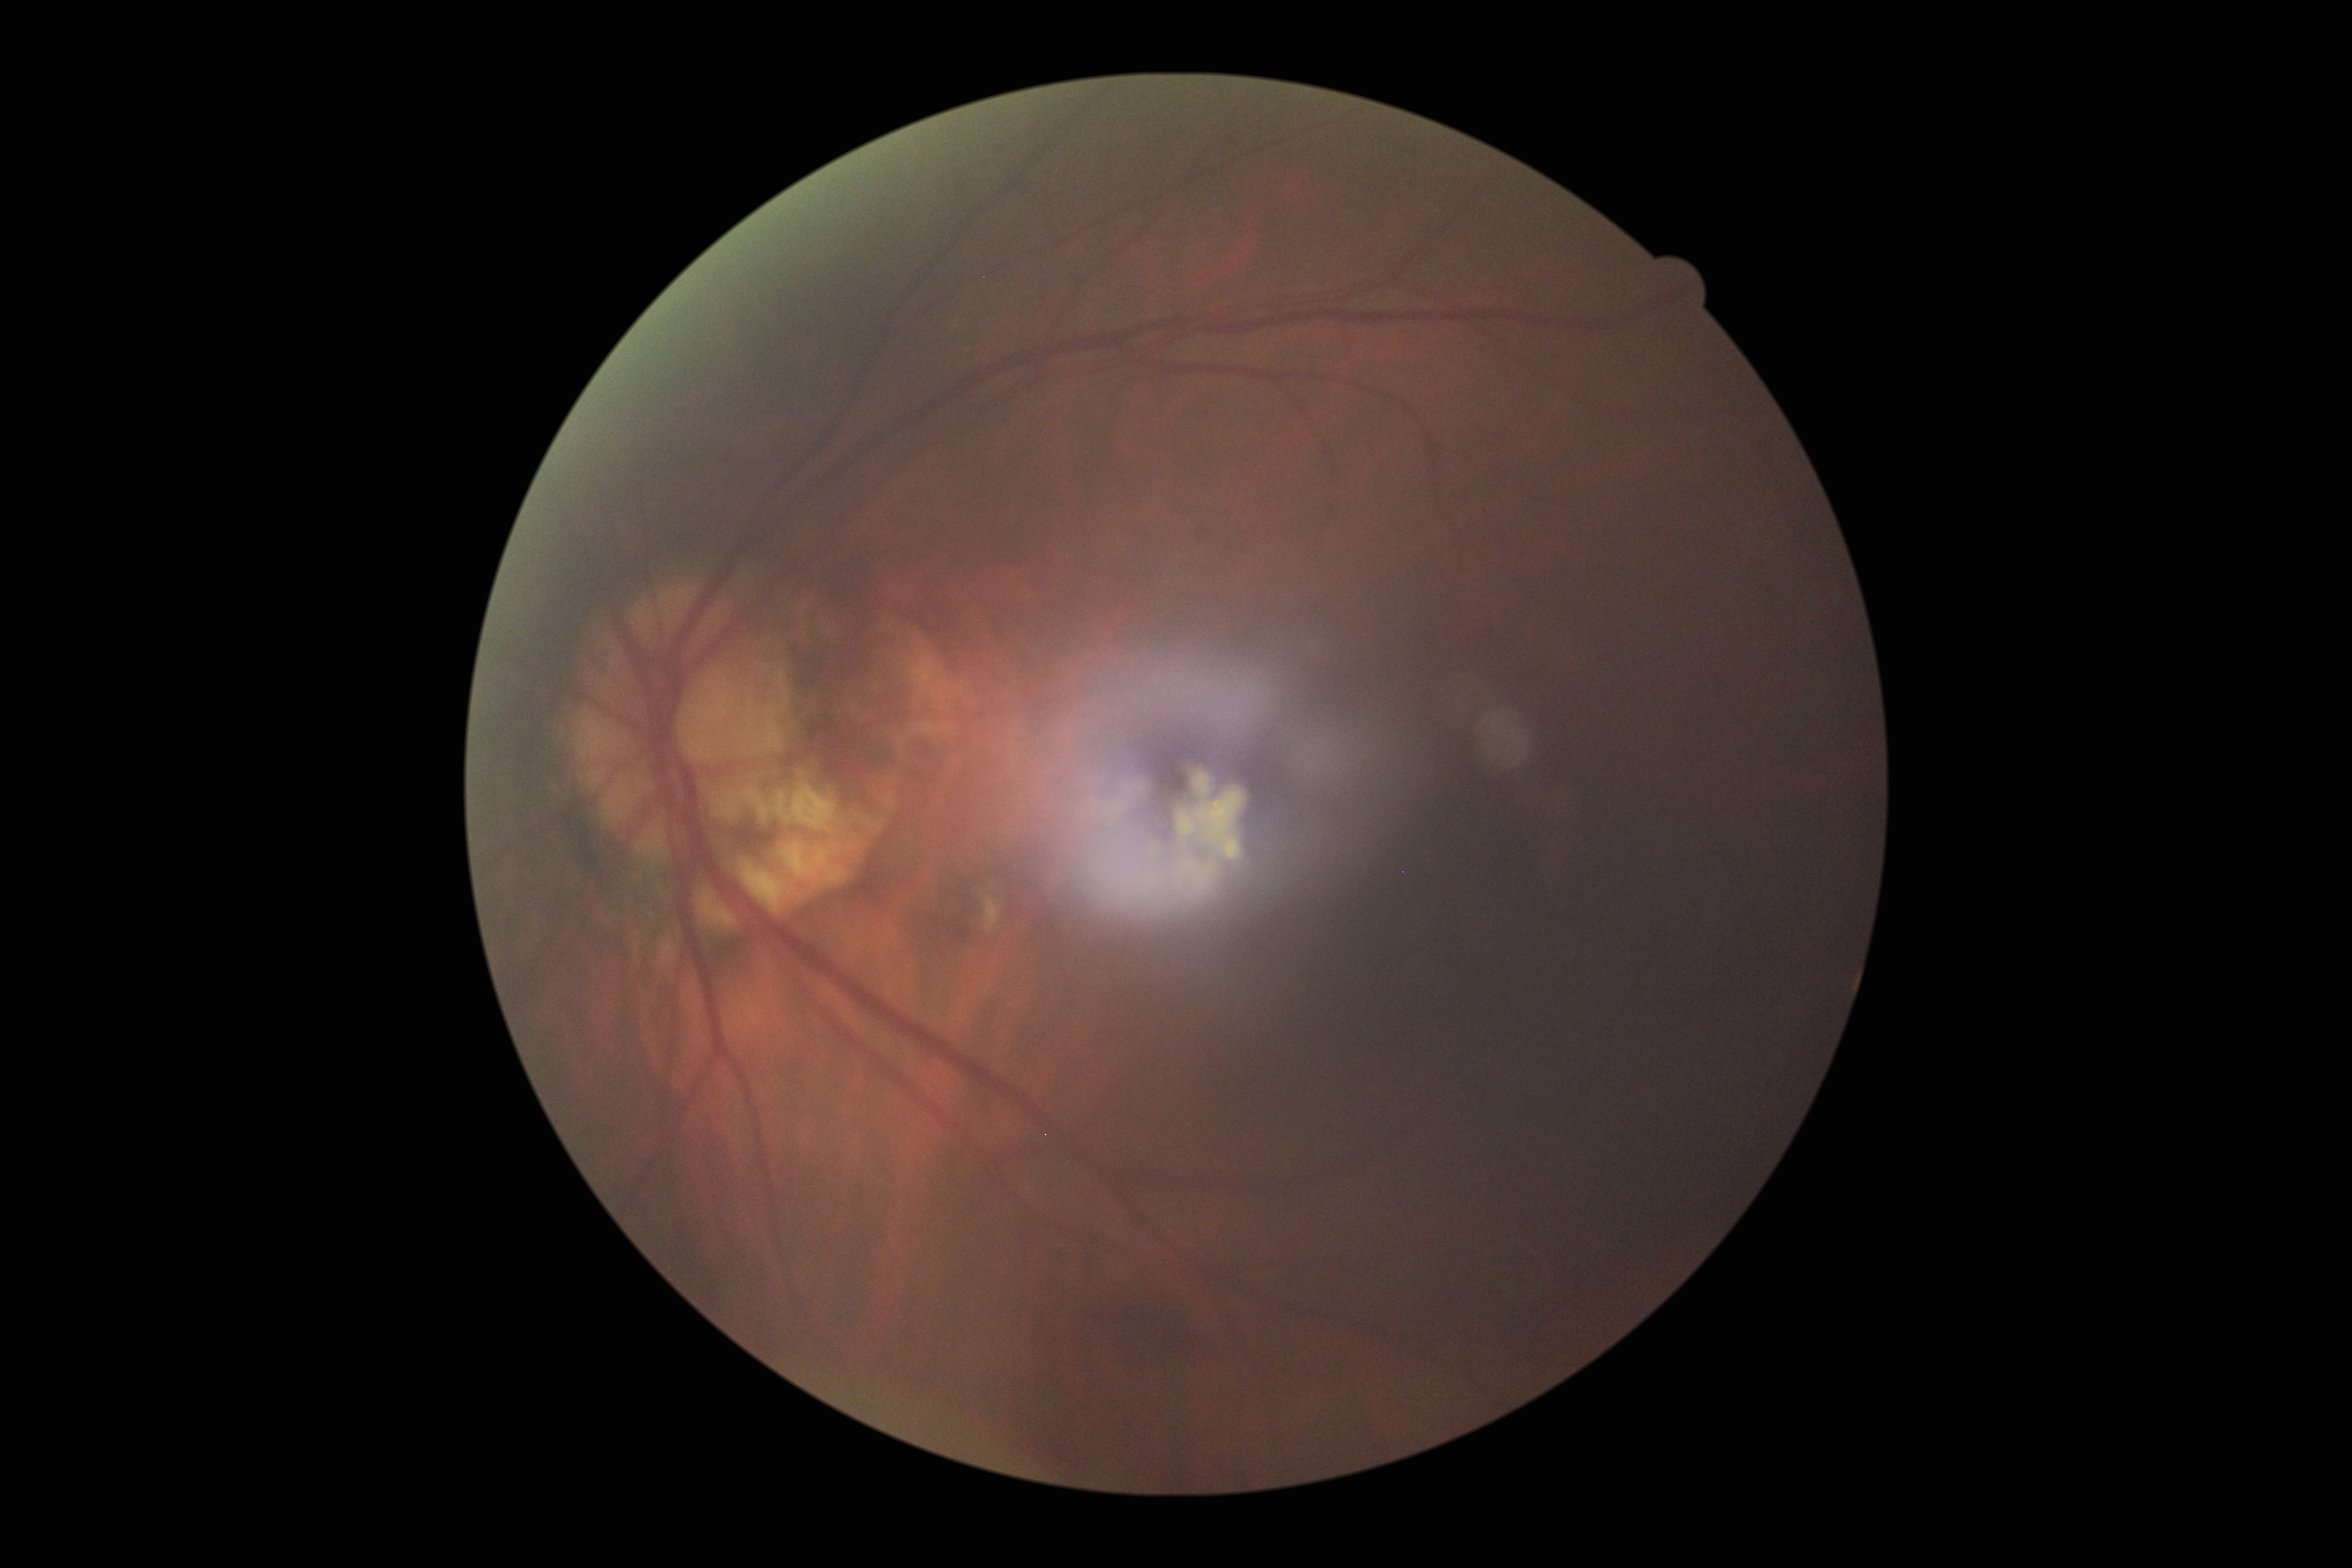
diabetic retinopathy (DR) = 2/4.